Non-mydriatic acquisition: 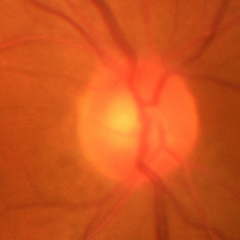

Glaucoma status: early glaucomatous optic neuropathy.